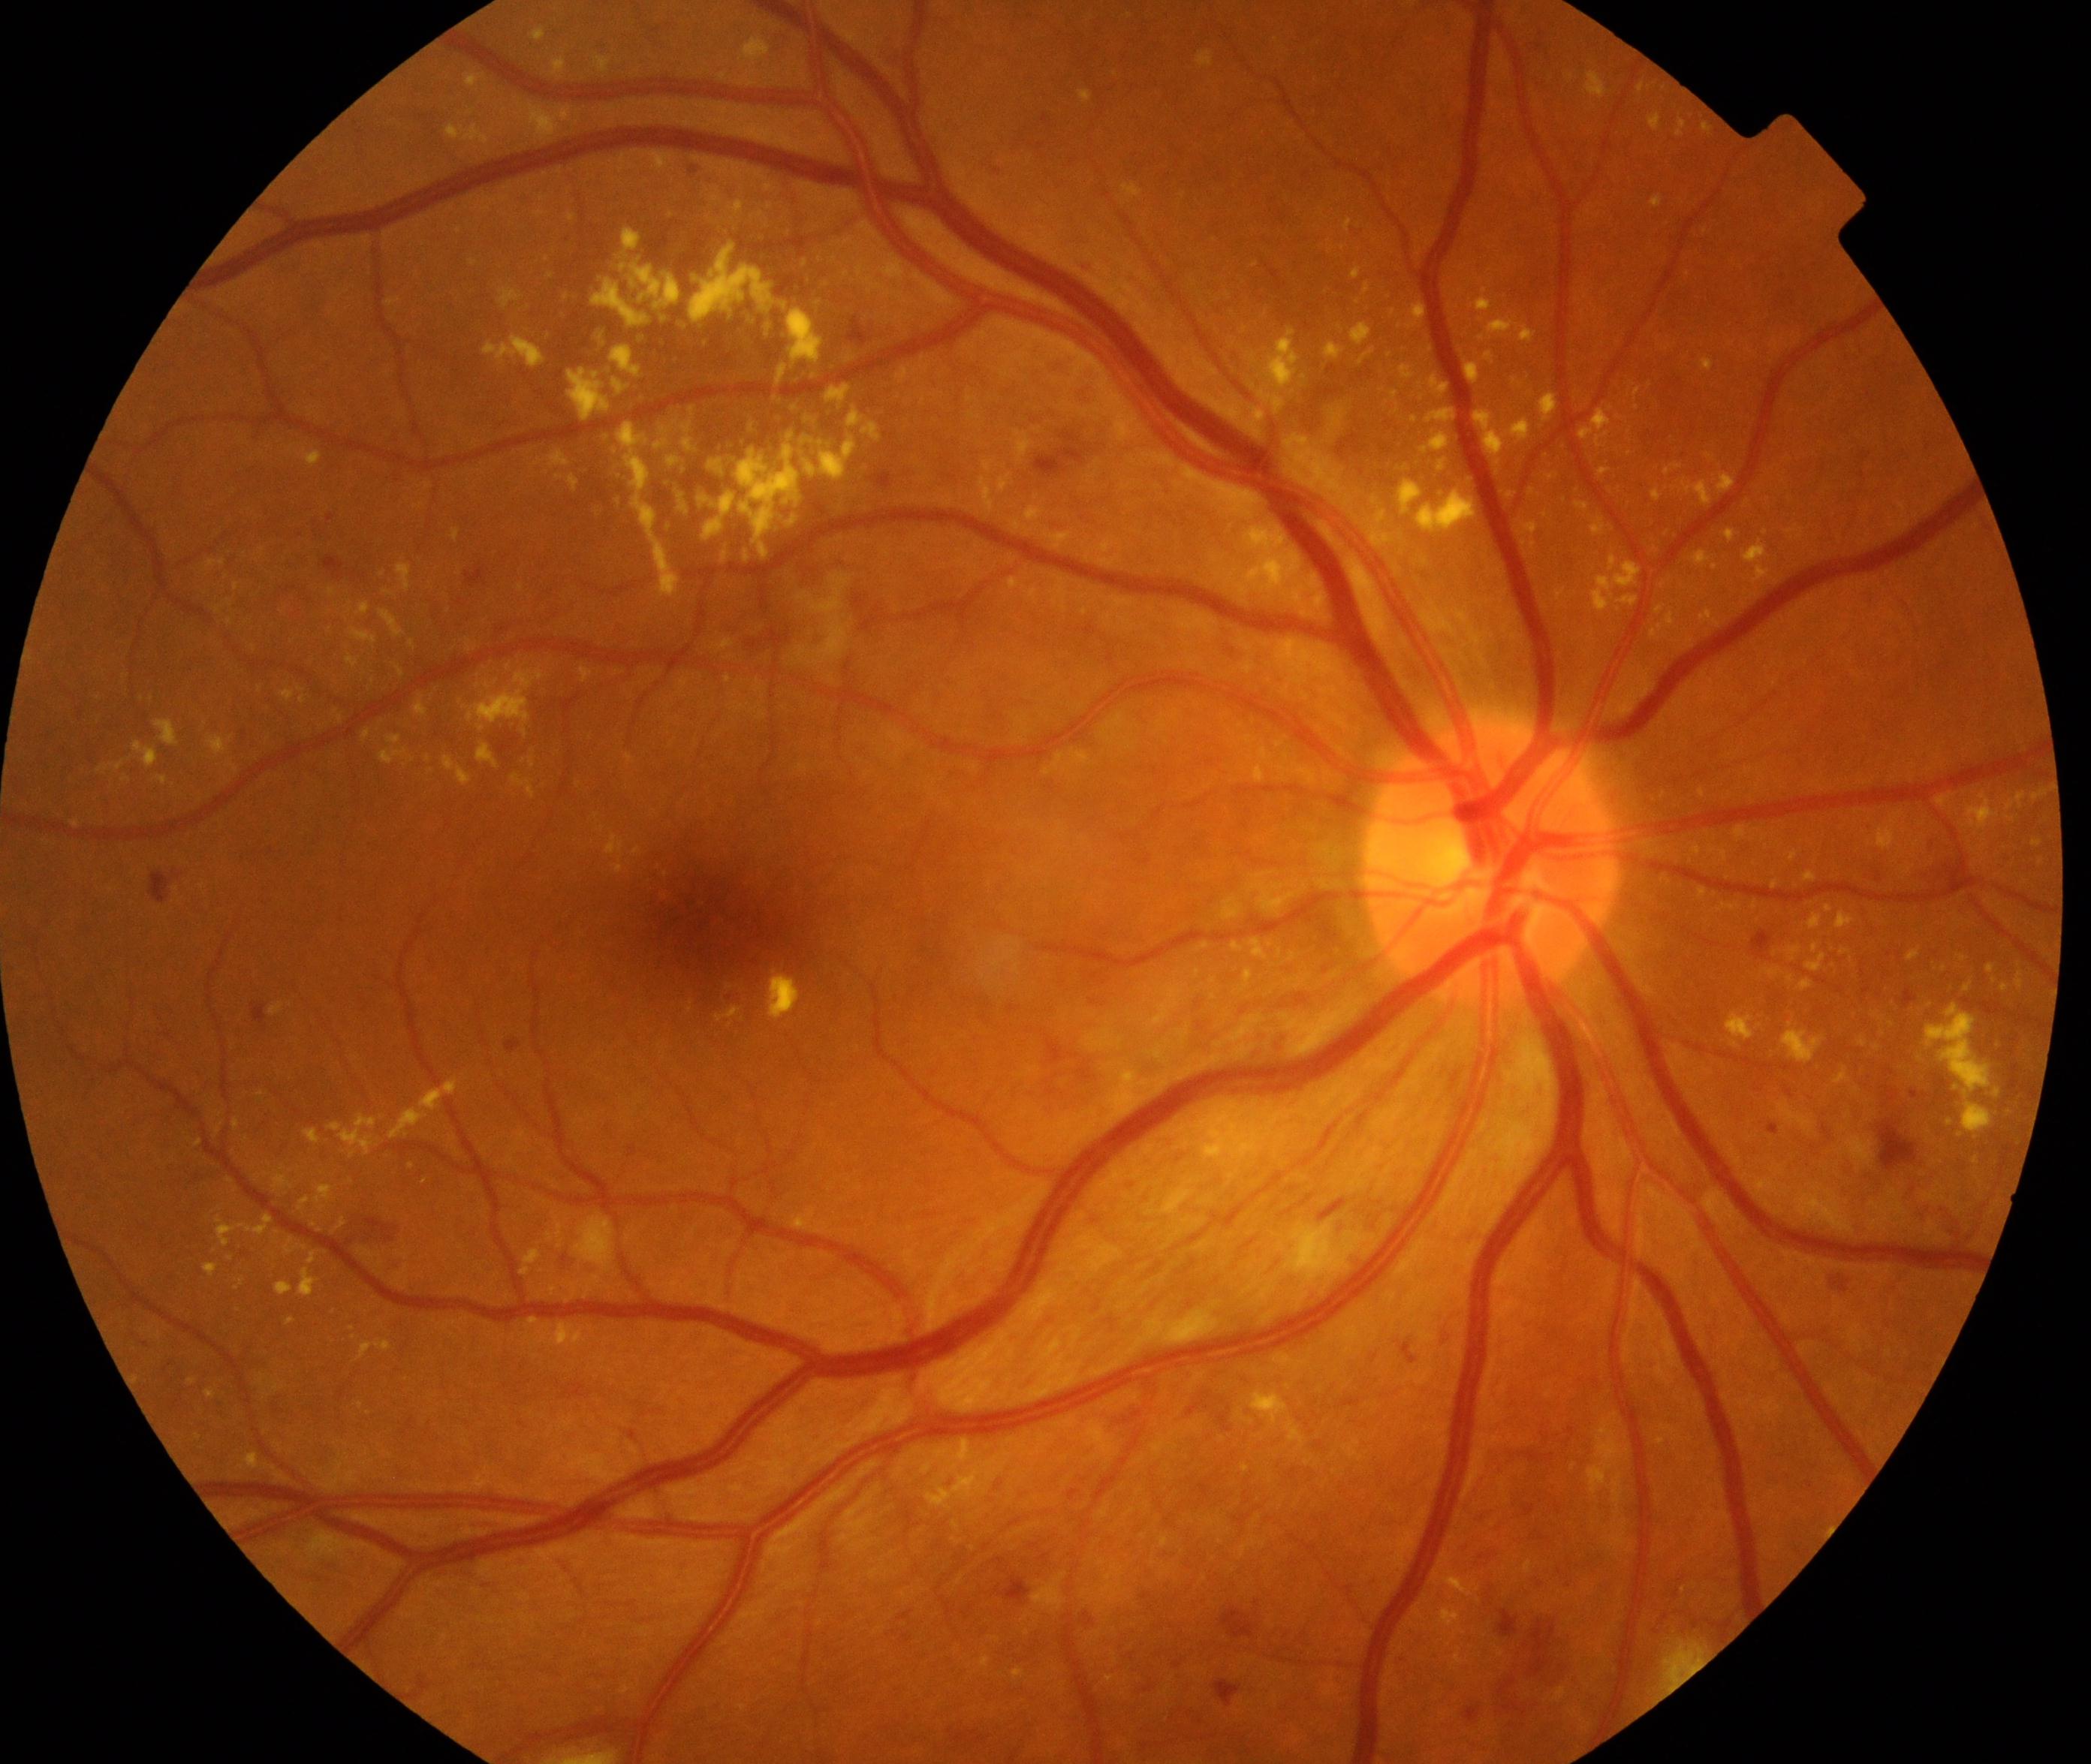

Fundus appearance consistent with moderate non-proliferative diabetic retinopathy. Characterized by microaneurysms with dot and blot hemorrhages or hard exudates, less than severe non-proliferative diabetic retinopathy, and/or with diabetic macular edema.